Fundus photo — 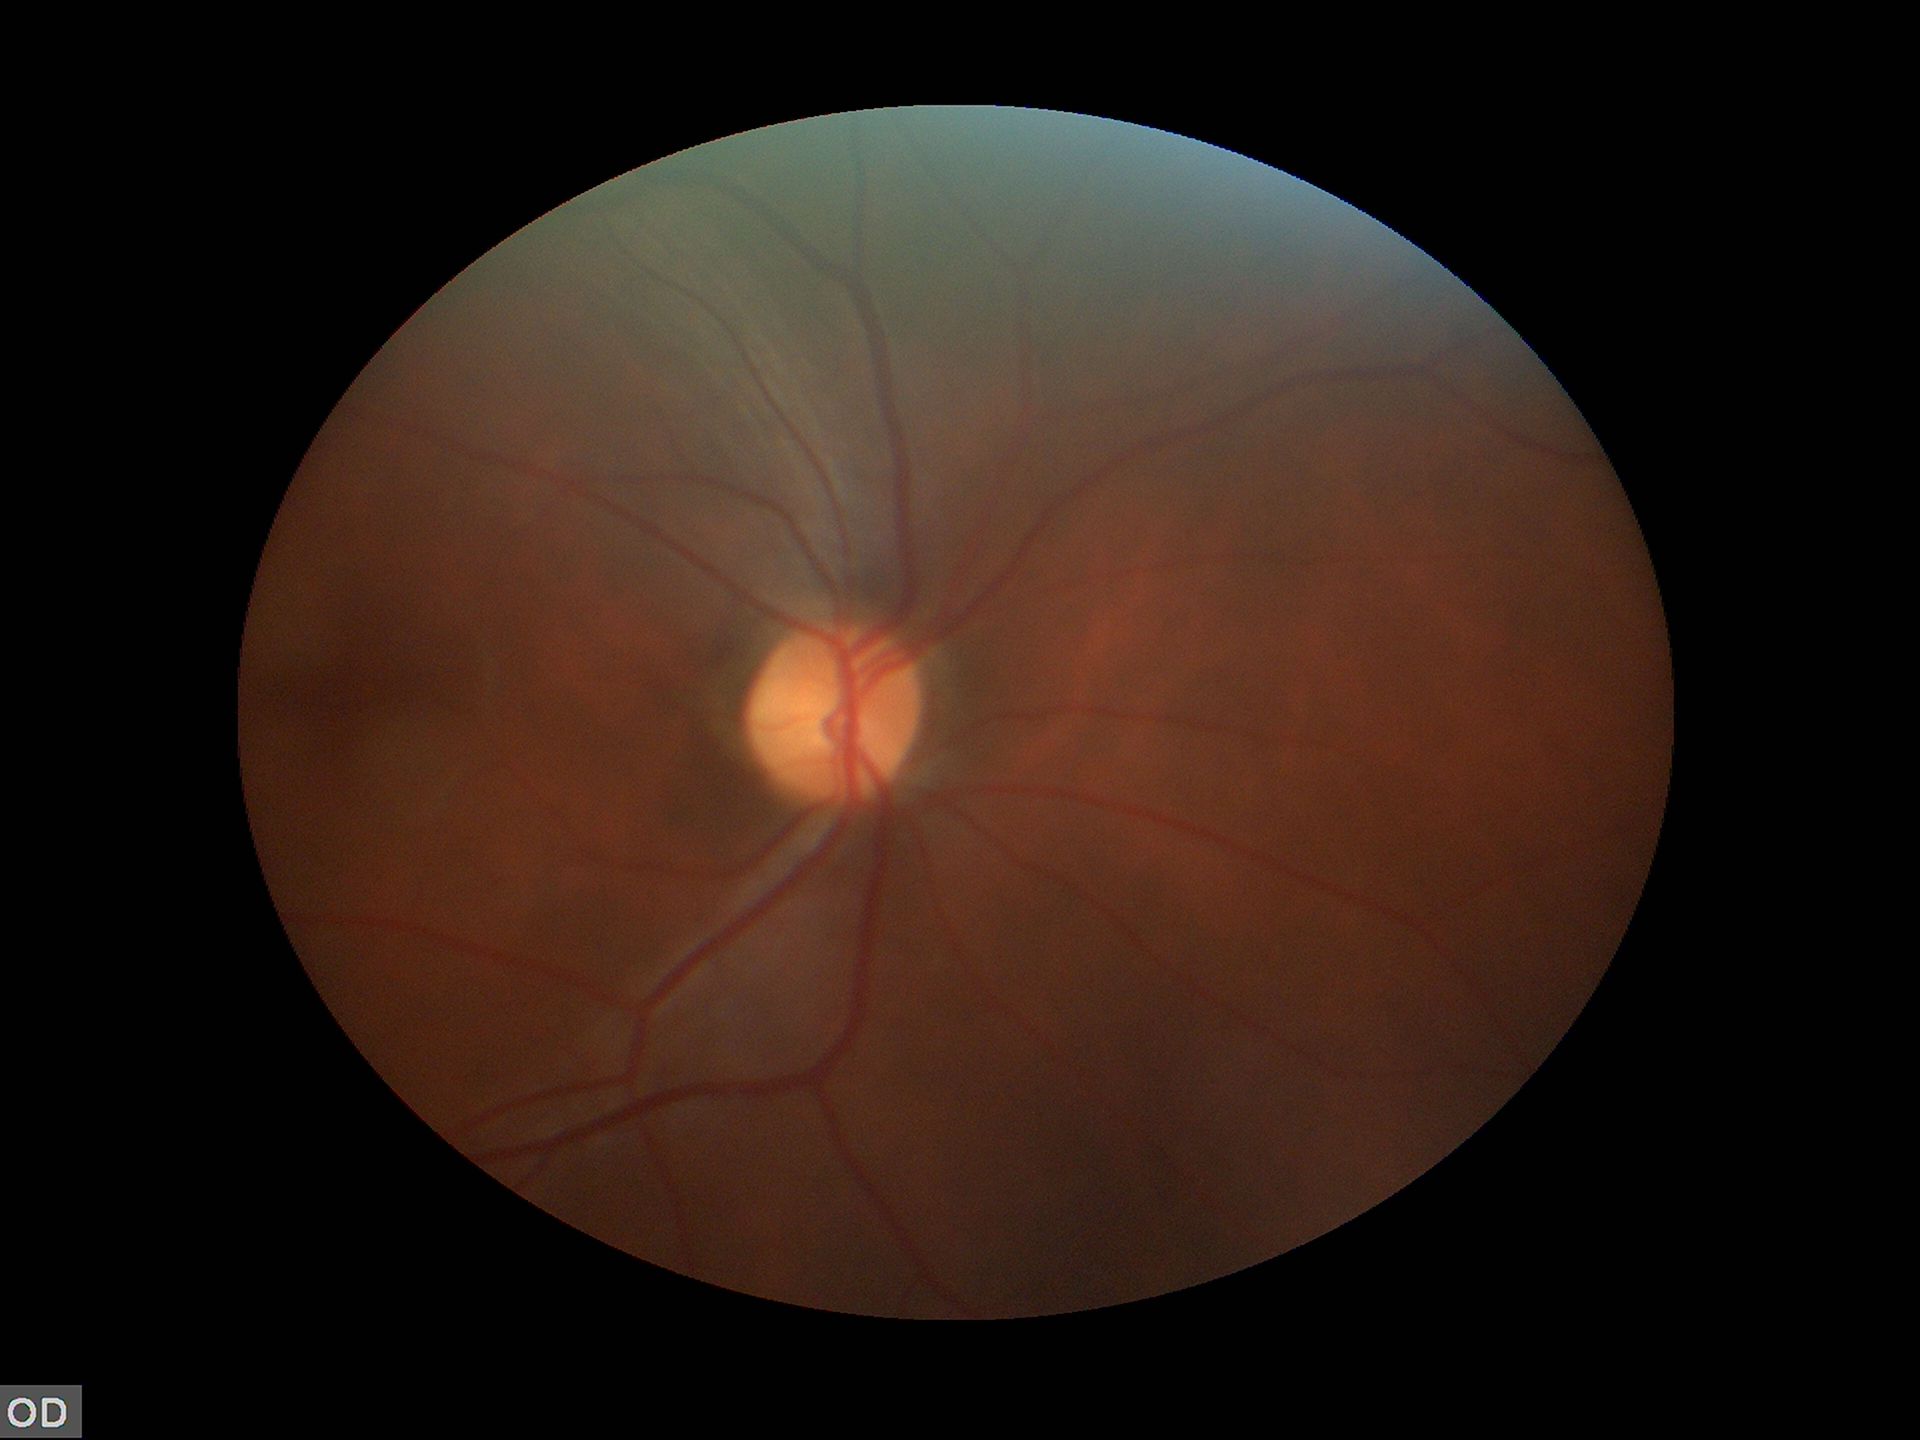
Annotations:
- vertical cup-disc ratio (VCDR) — 0.49
- Glaucoma impression — no suspicious findings